Infant wide-field fundus photograph:
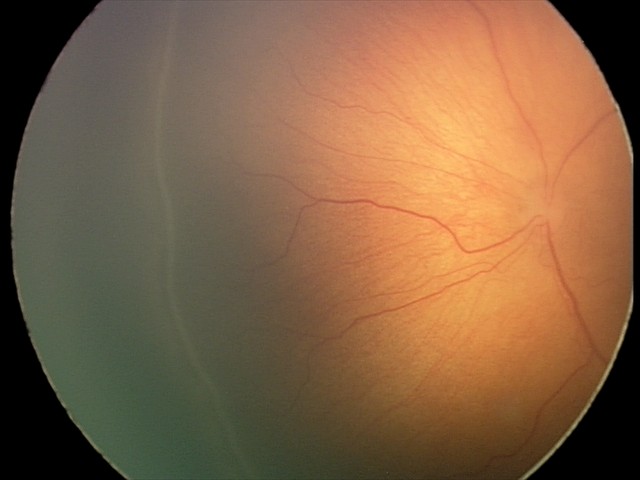

Assessment: no plus disease | ROP stage 2.